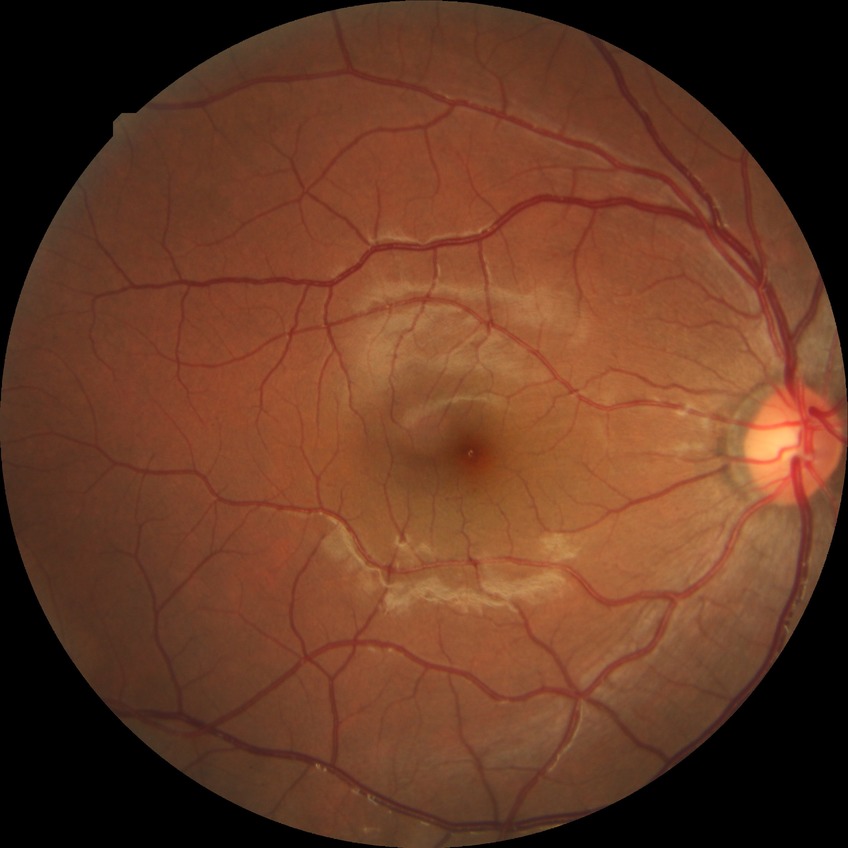

Diabetic retinopathy severity is no diabetic retinopathy.